NIDEK AFC-230 fundus camera — 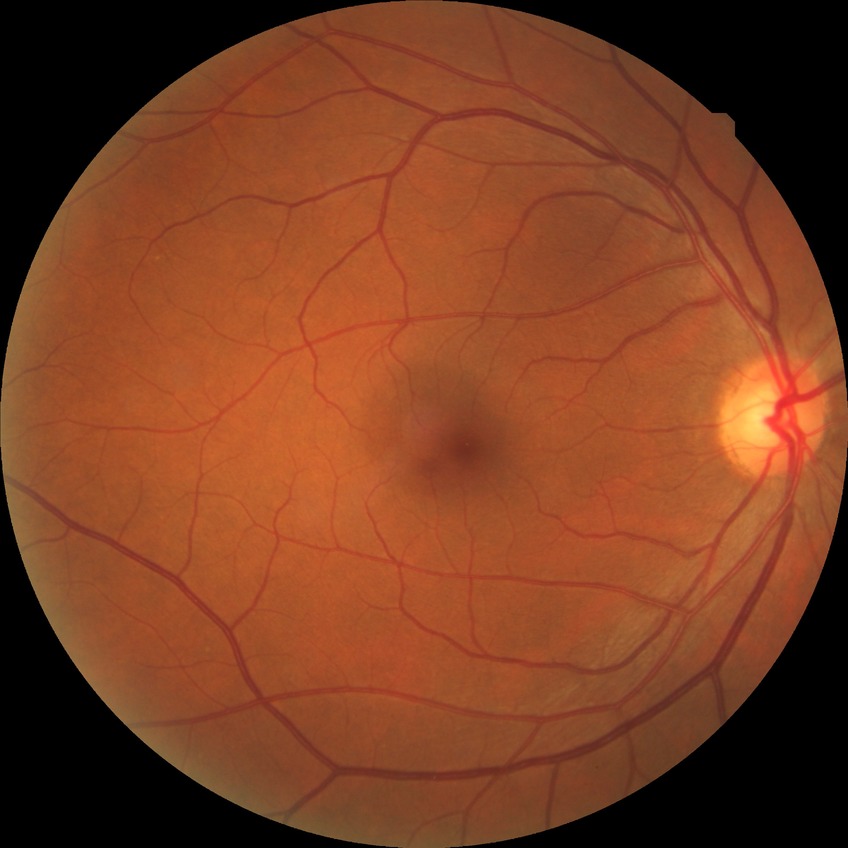

Modified Davis classification is no diabetic retinopathy.